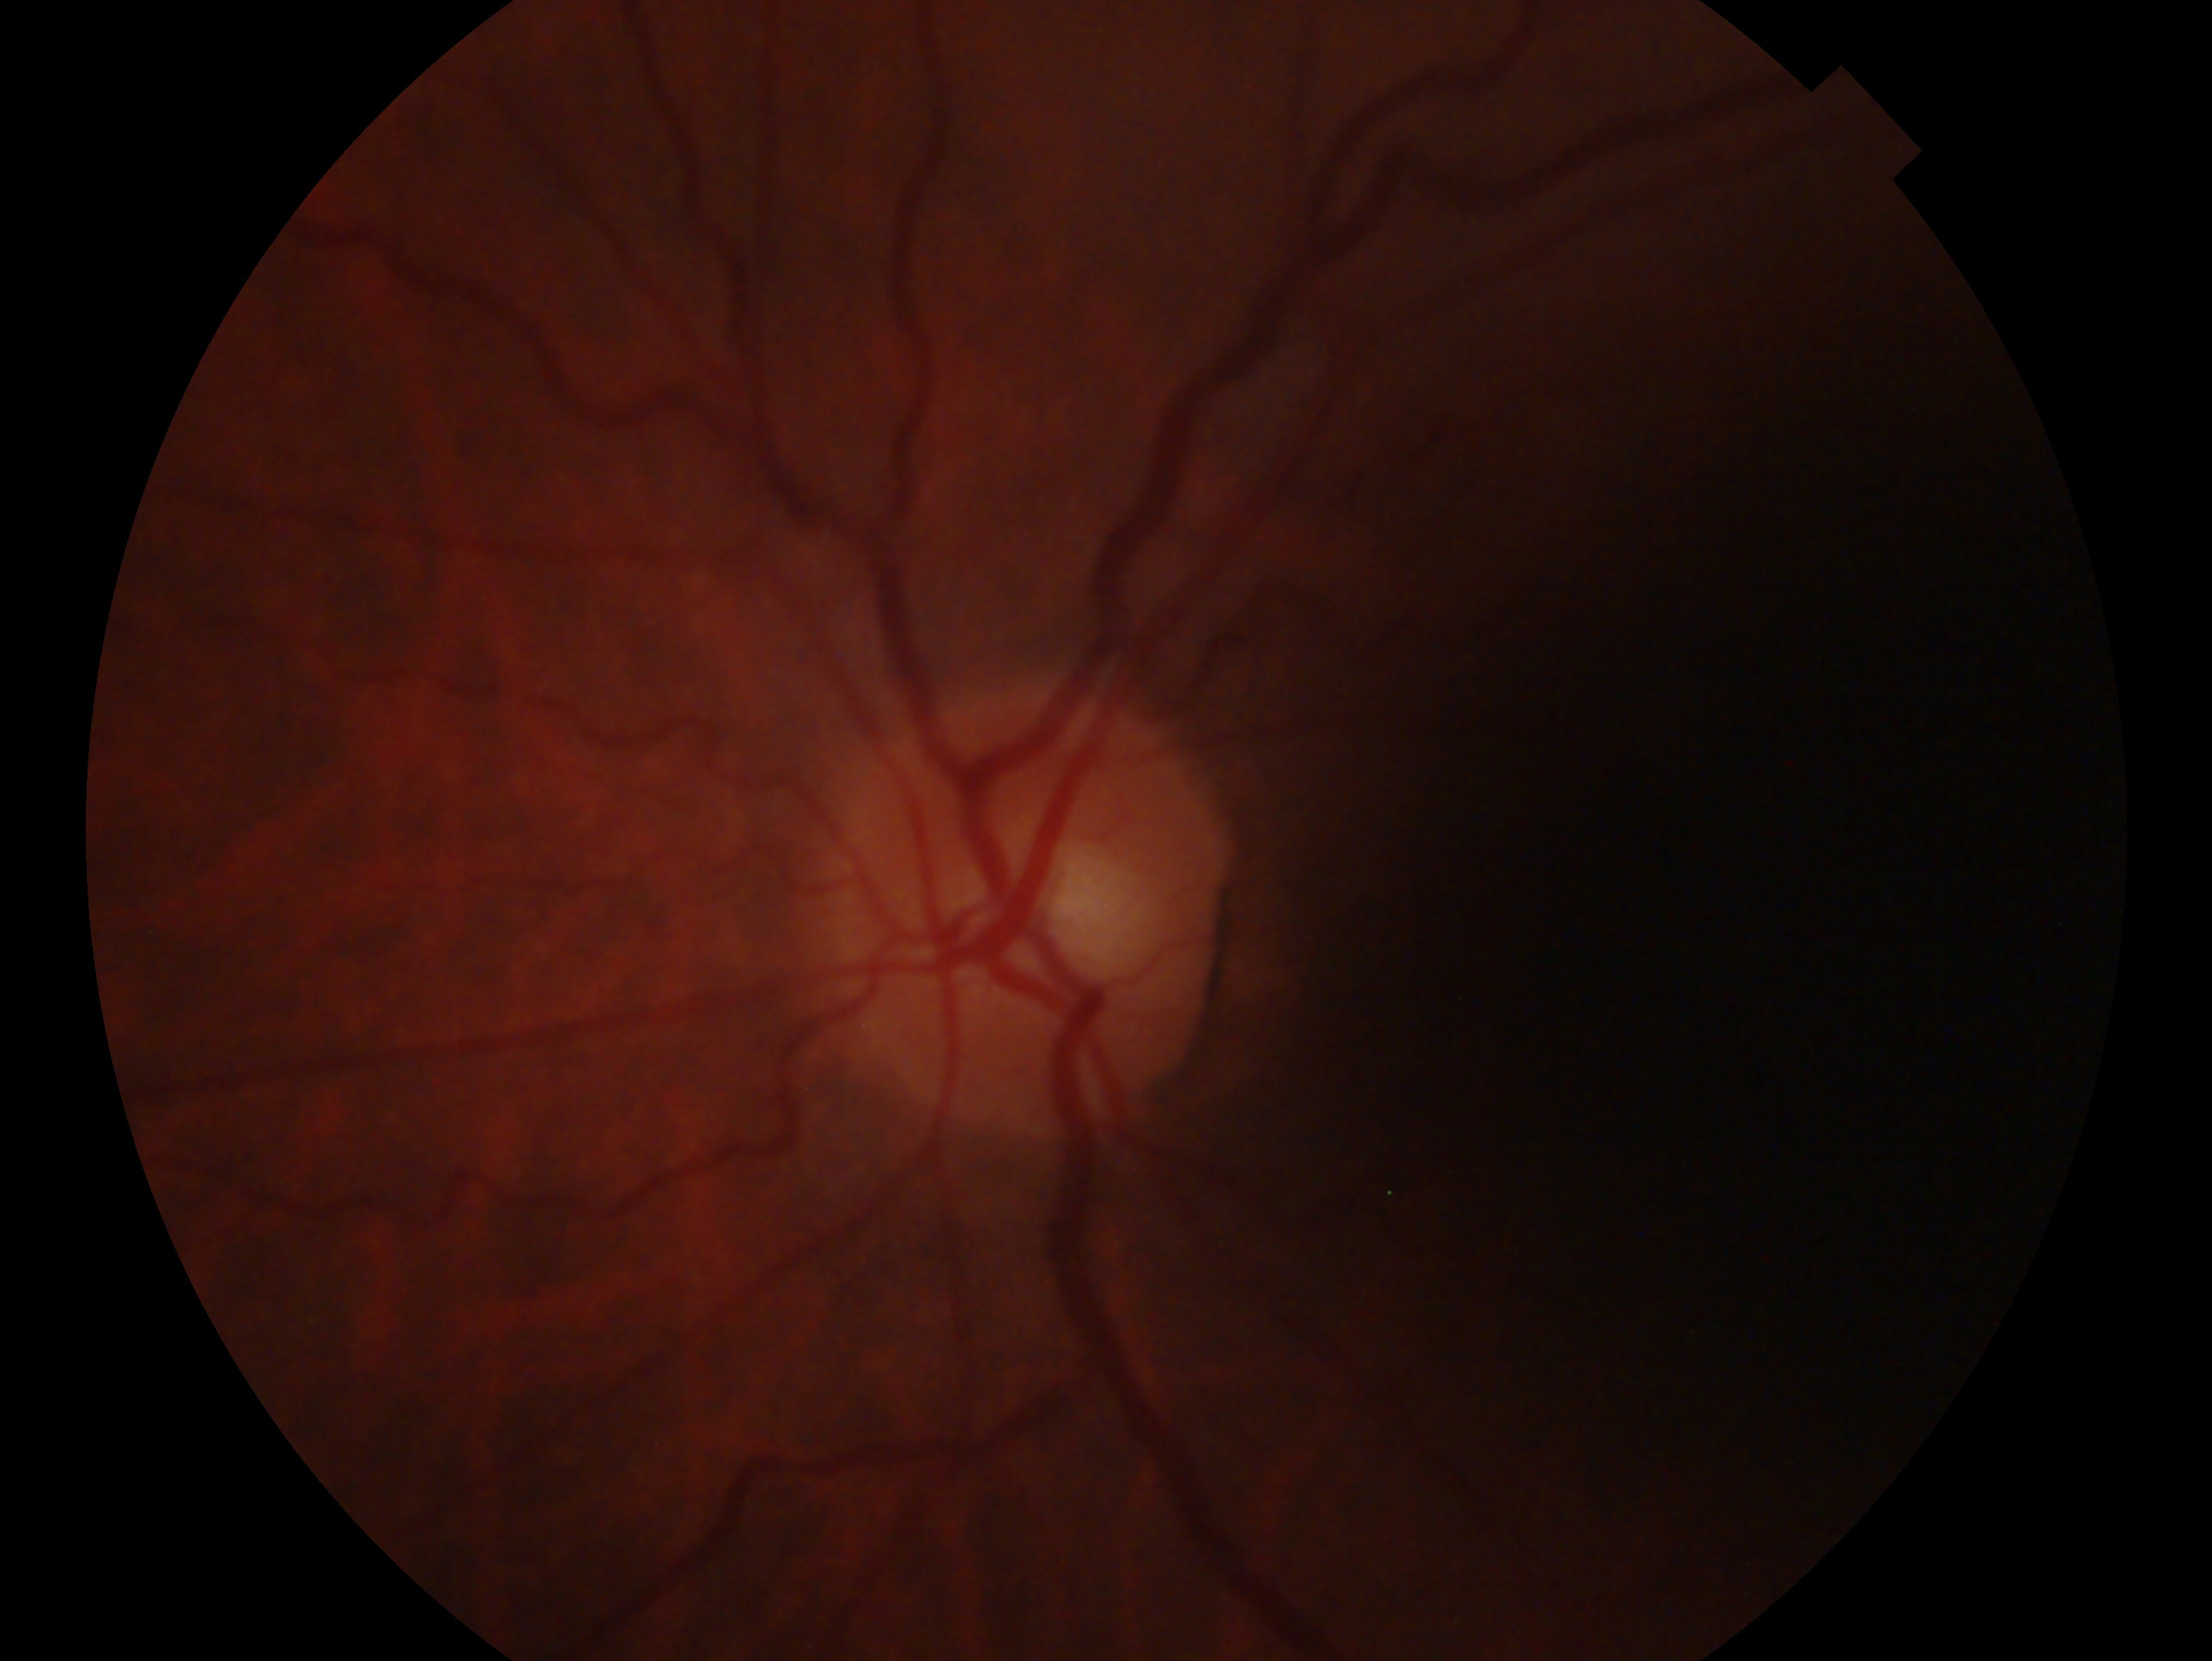
Glaucoma assessment — no glaucoma. The image shows the left eye.